Without pupil dilation. 45 degree fundus photograph. Modified Davis grading
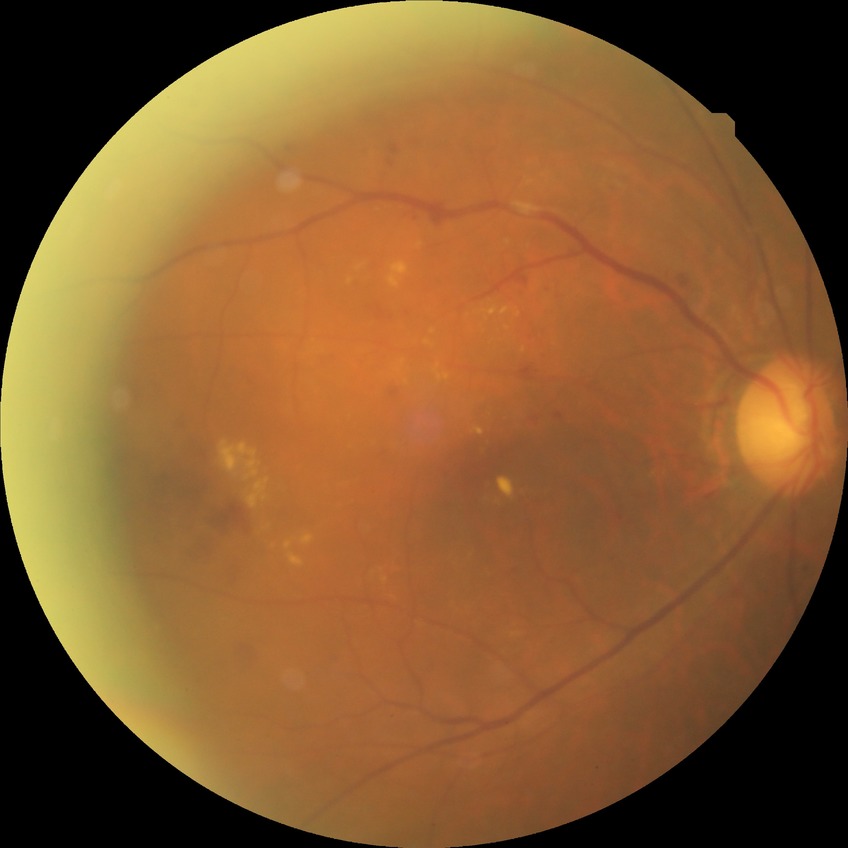

Assessment:
* DR class — non-proliferative diabetic retinopathy
* retinopathy grade — simple diabetic retinopathy